Color fundus photograph.
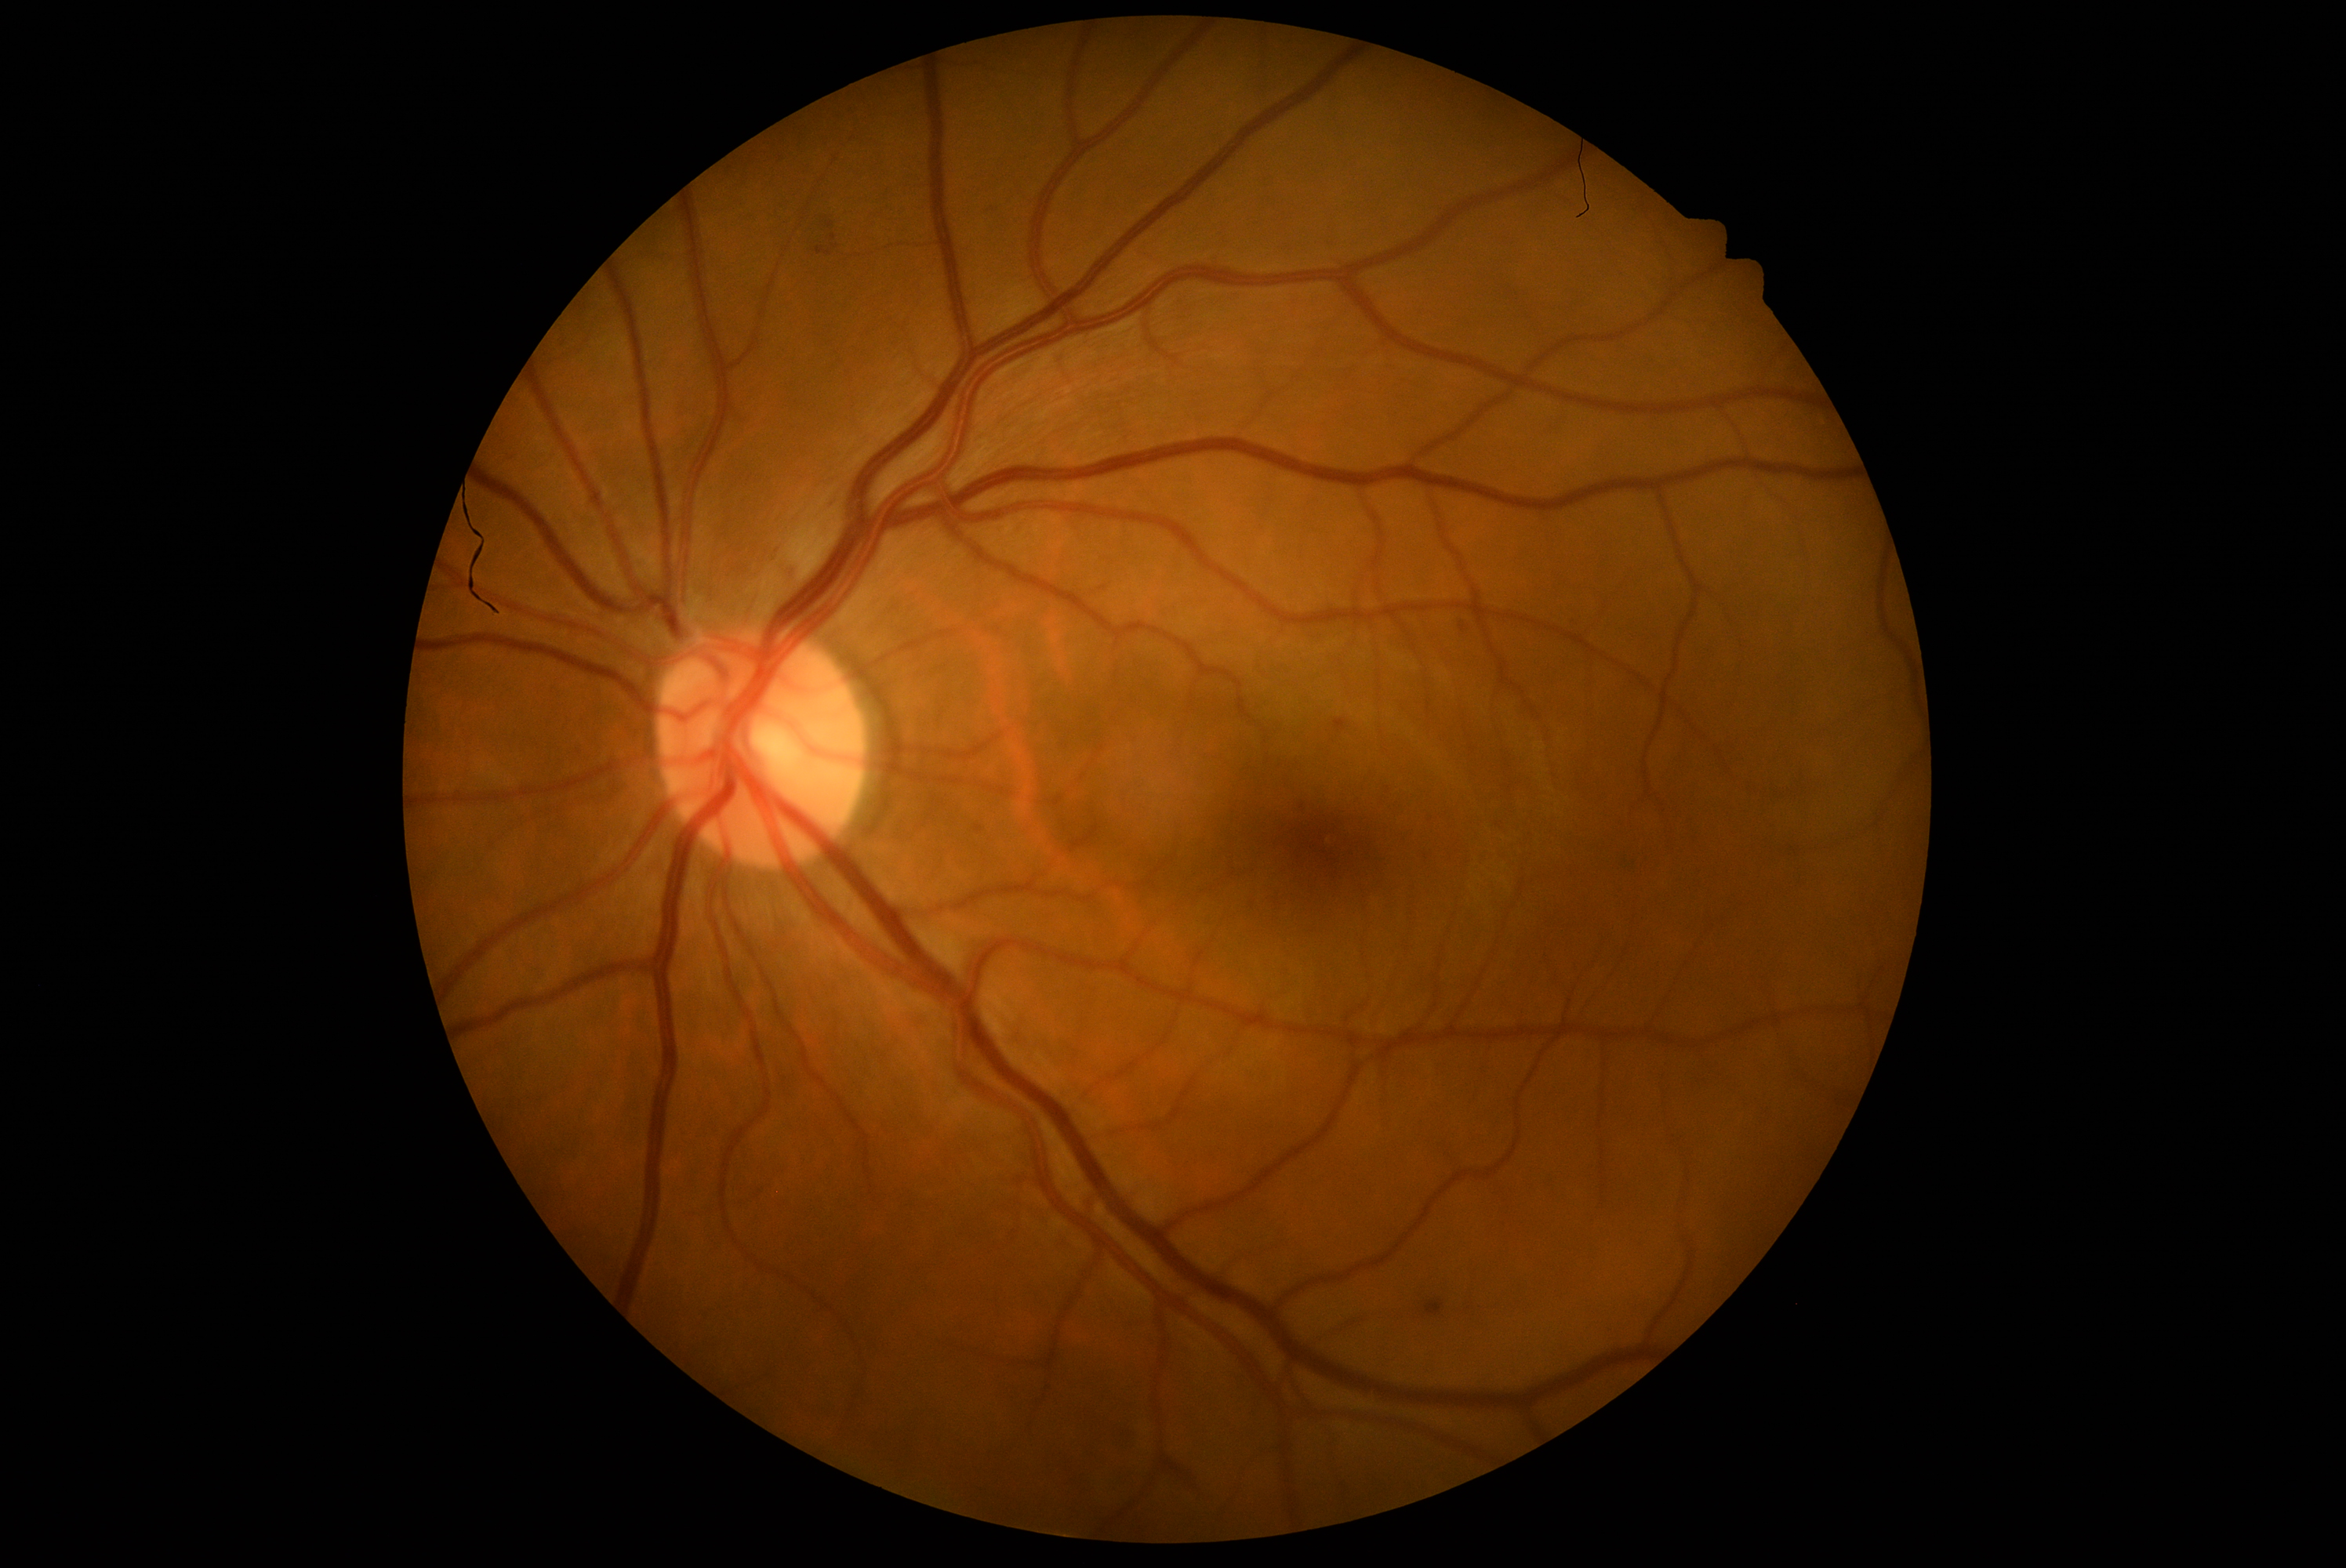 • DR severity: moderate NPDR (grade 2)